45° FOV, retinal fundus photograph, 1932 by 1916 pixels: 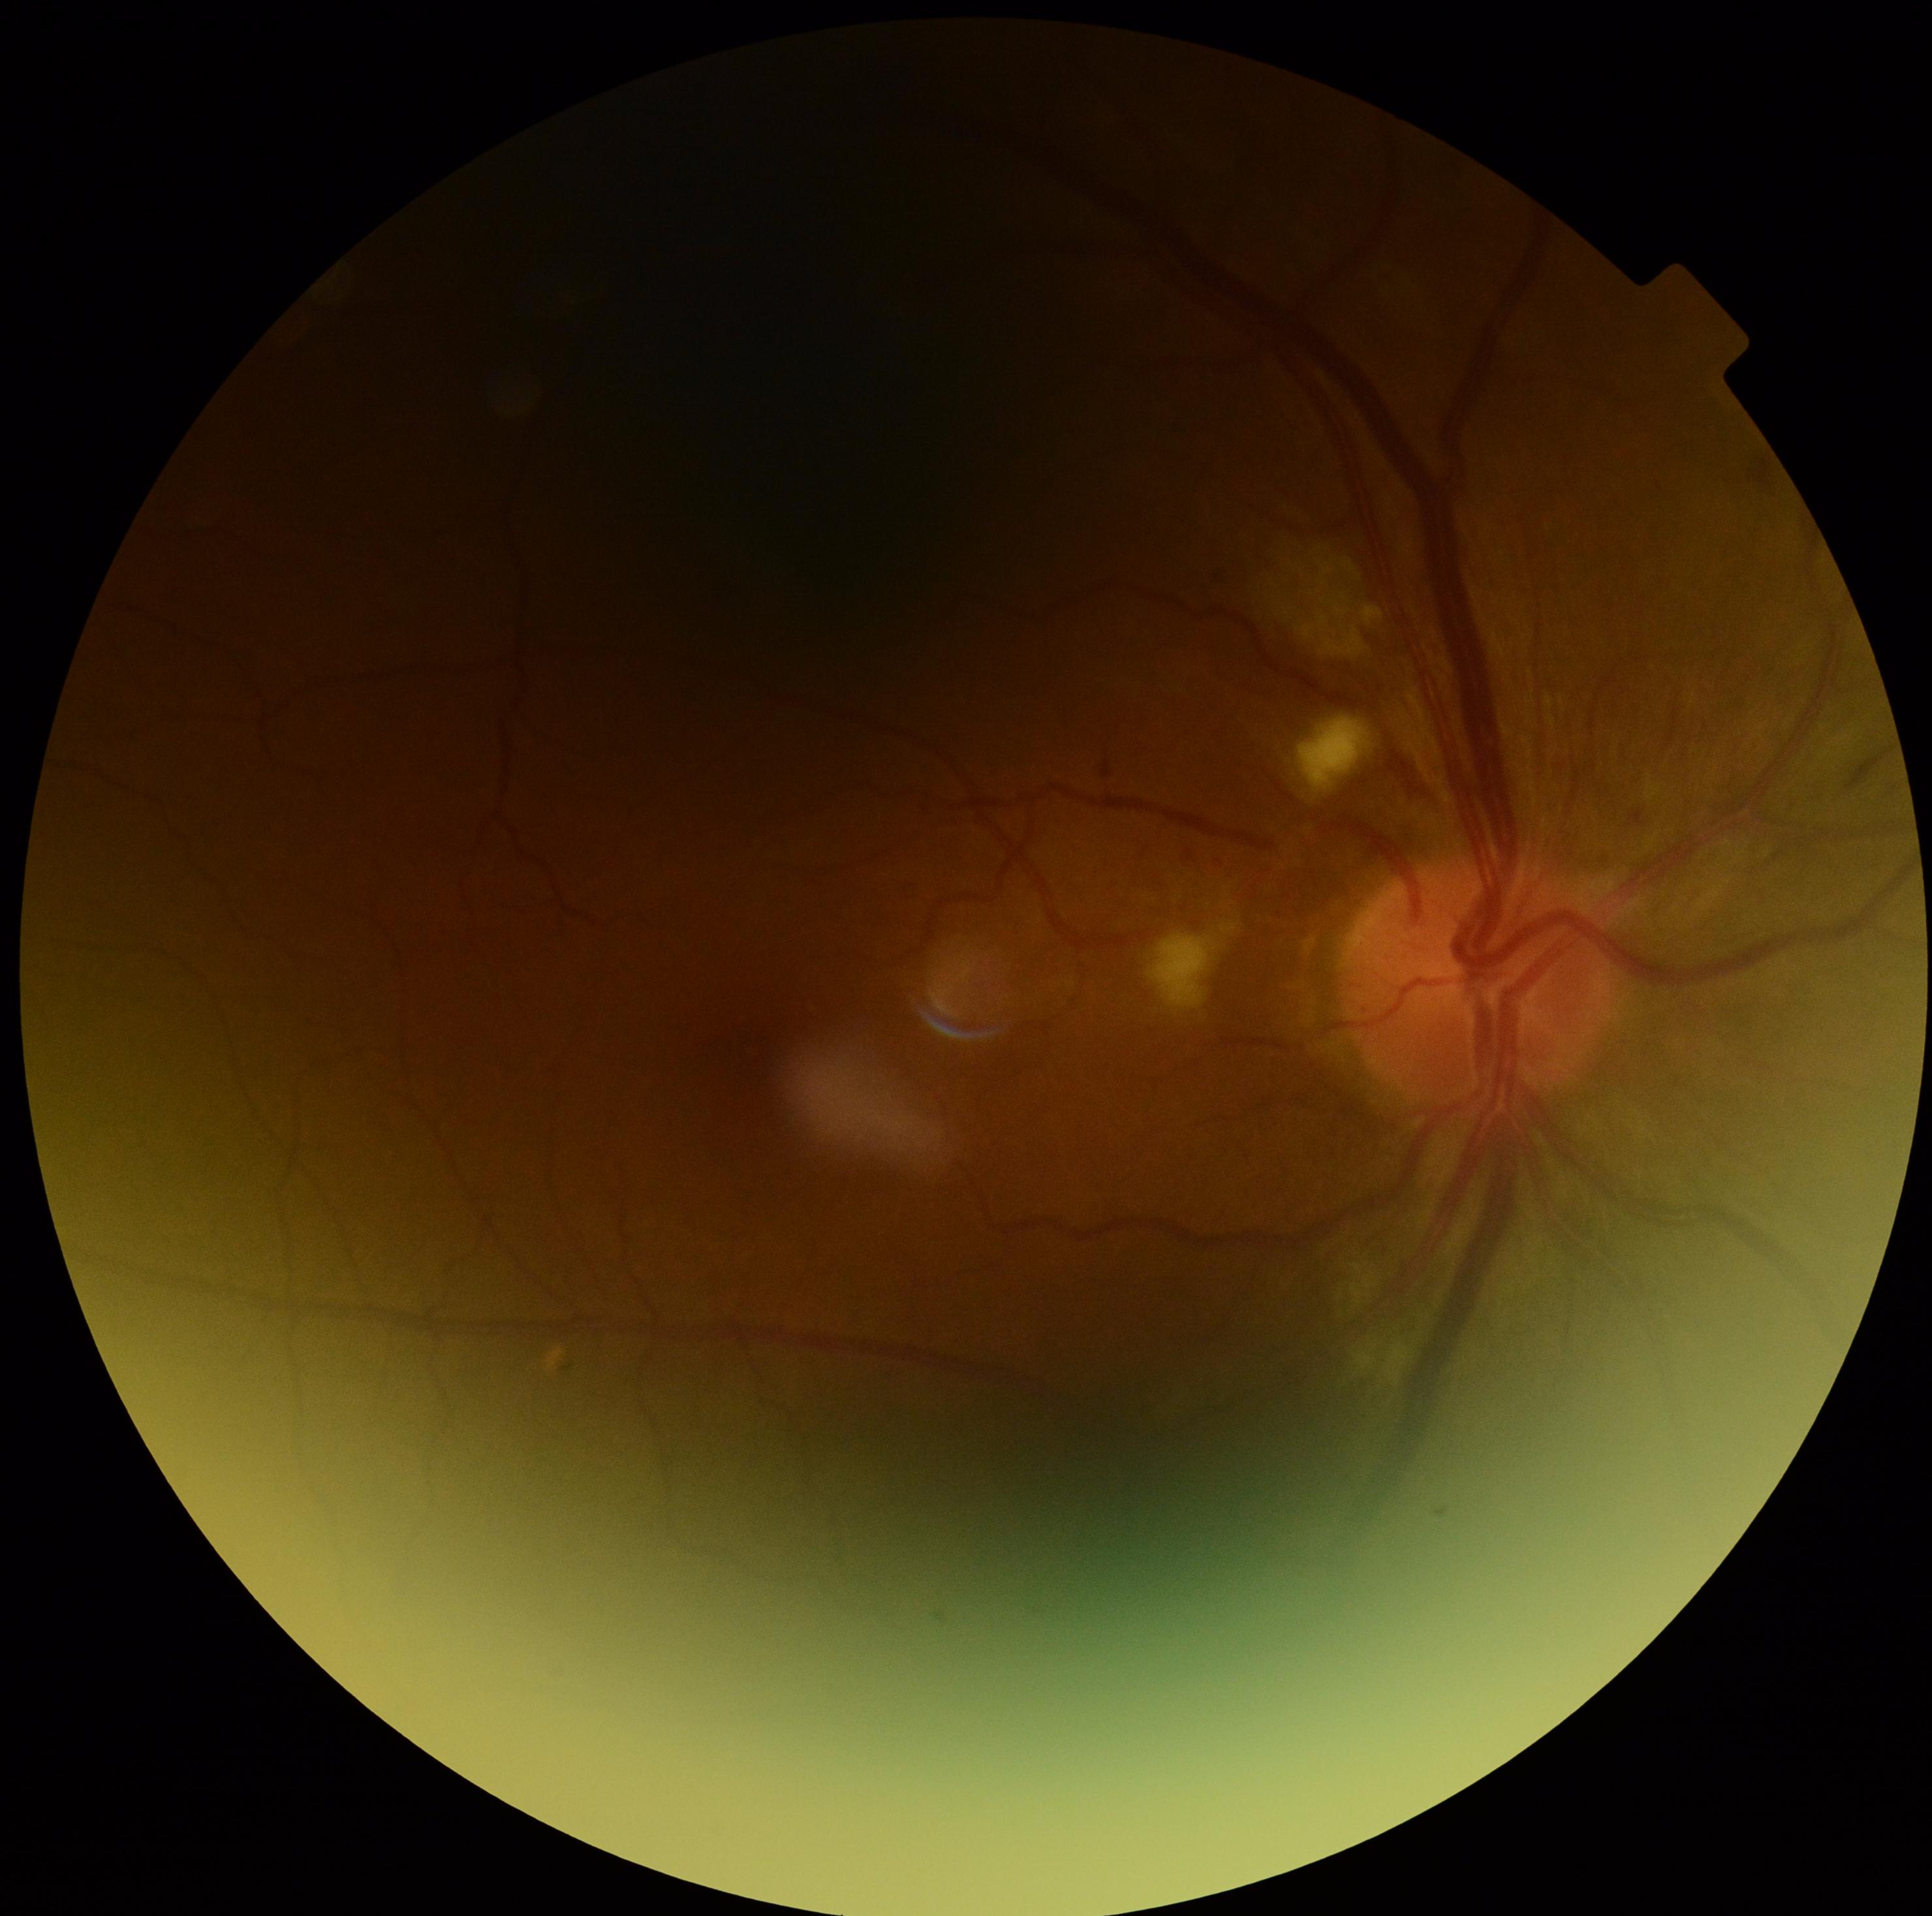

DR severity: moderate NPDR (grade 2).